Corneal thickness: 573 µm; refraction: +2 -1.5 × 95°; axial length (AL) 23.87 mm.
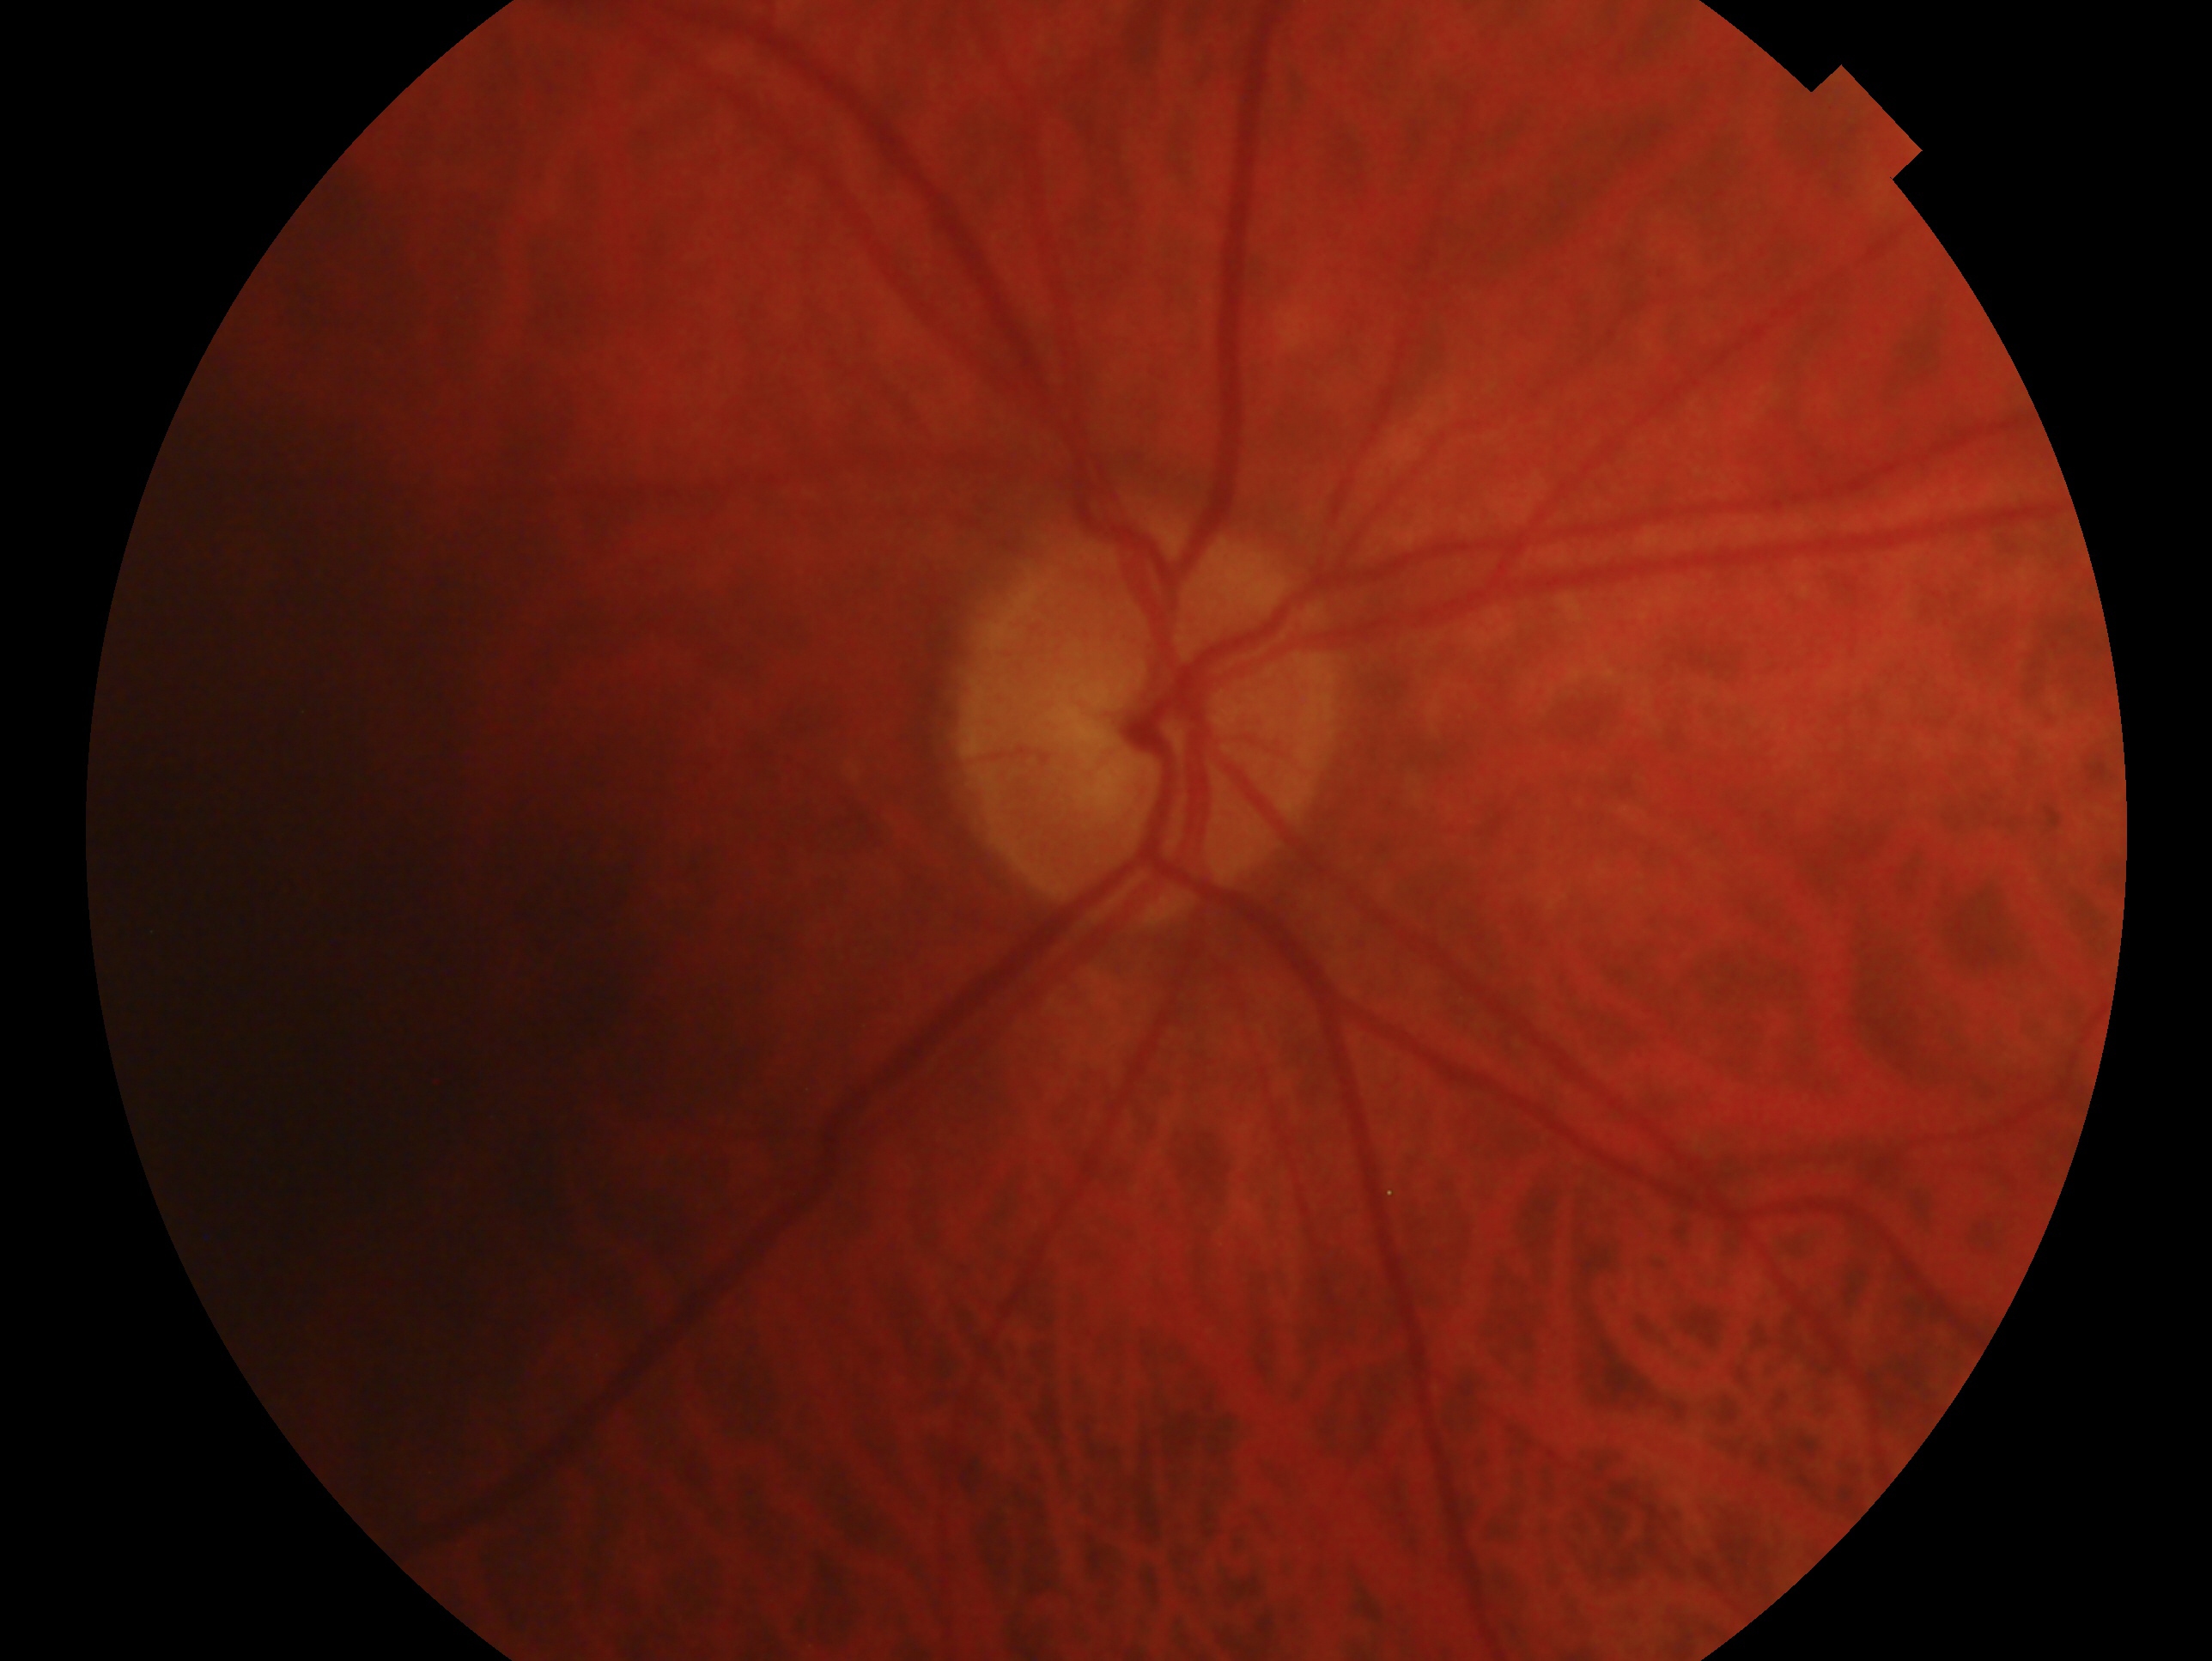
The image shows the OD.
Glaucoma status: glaucomatous optic neuropathy.